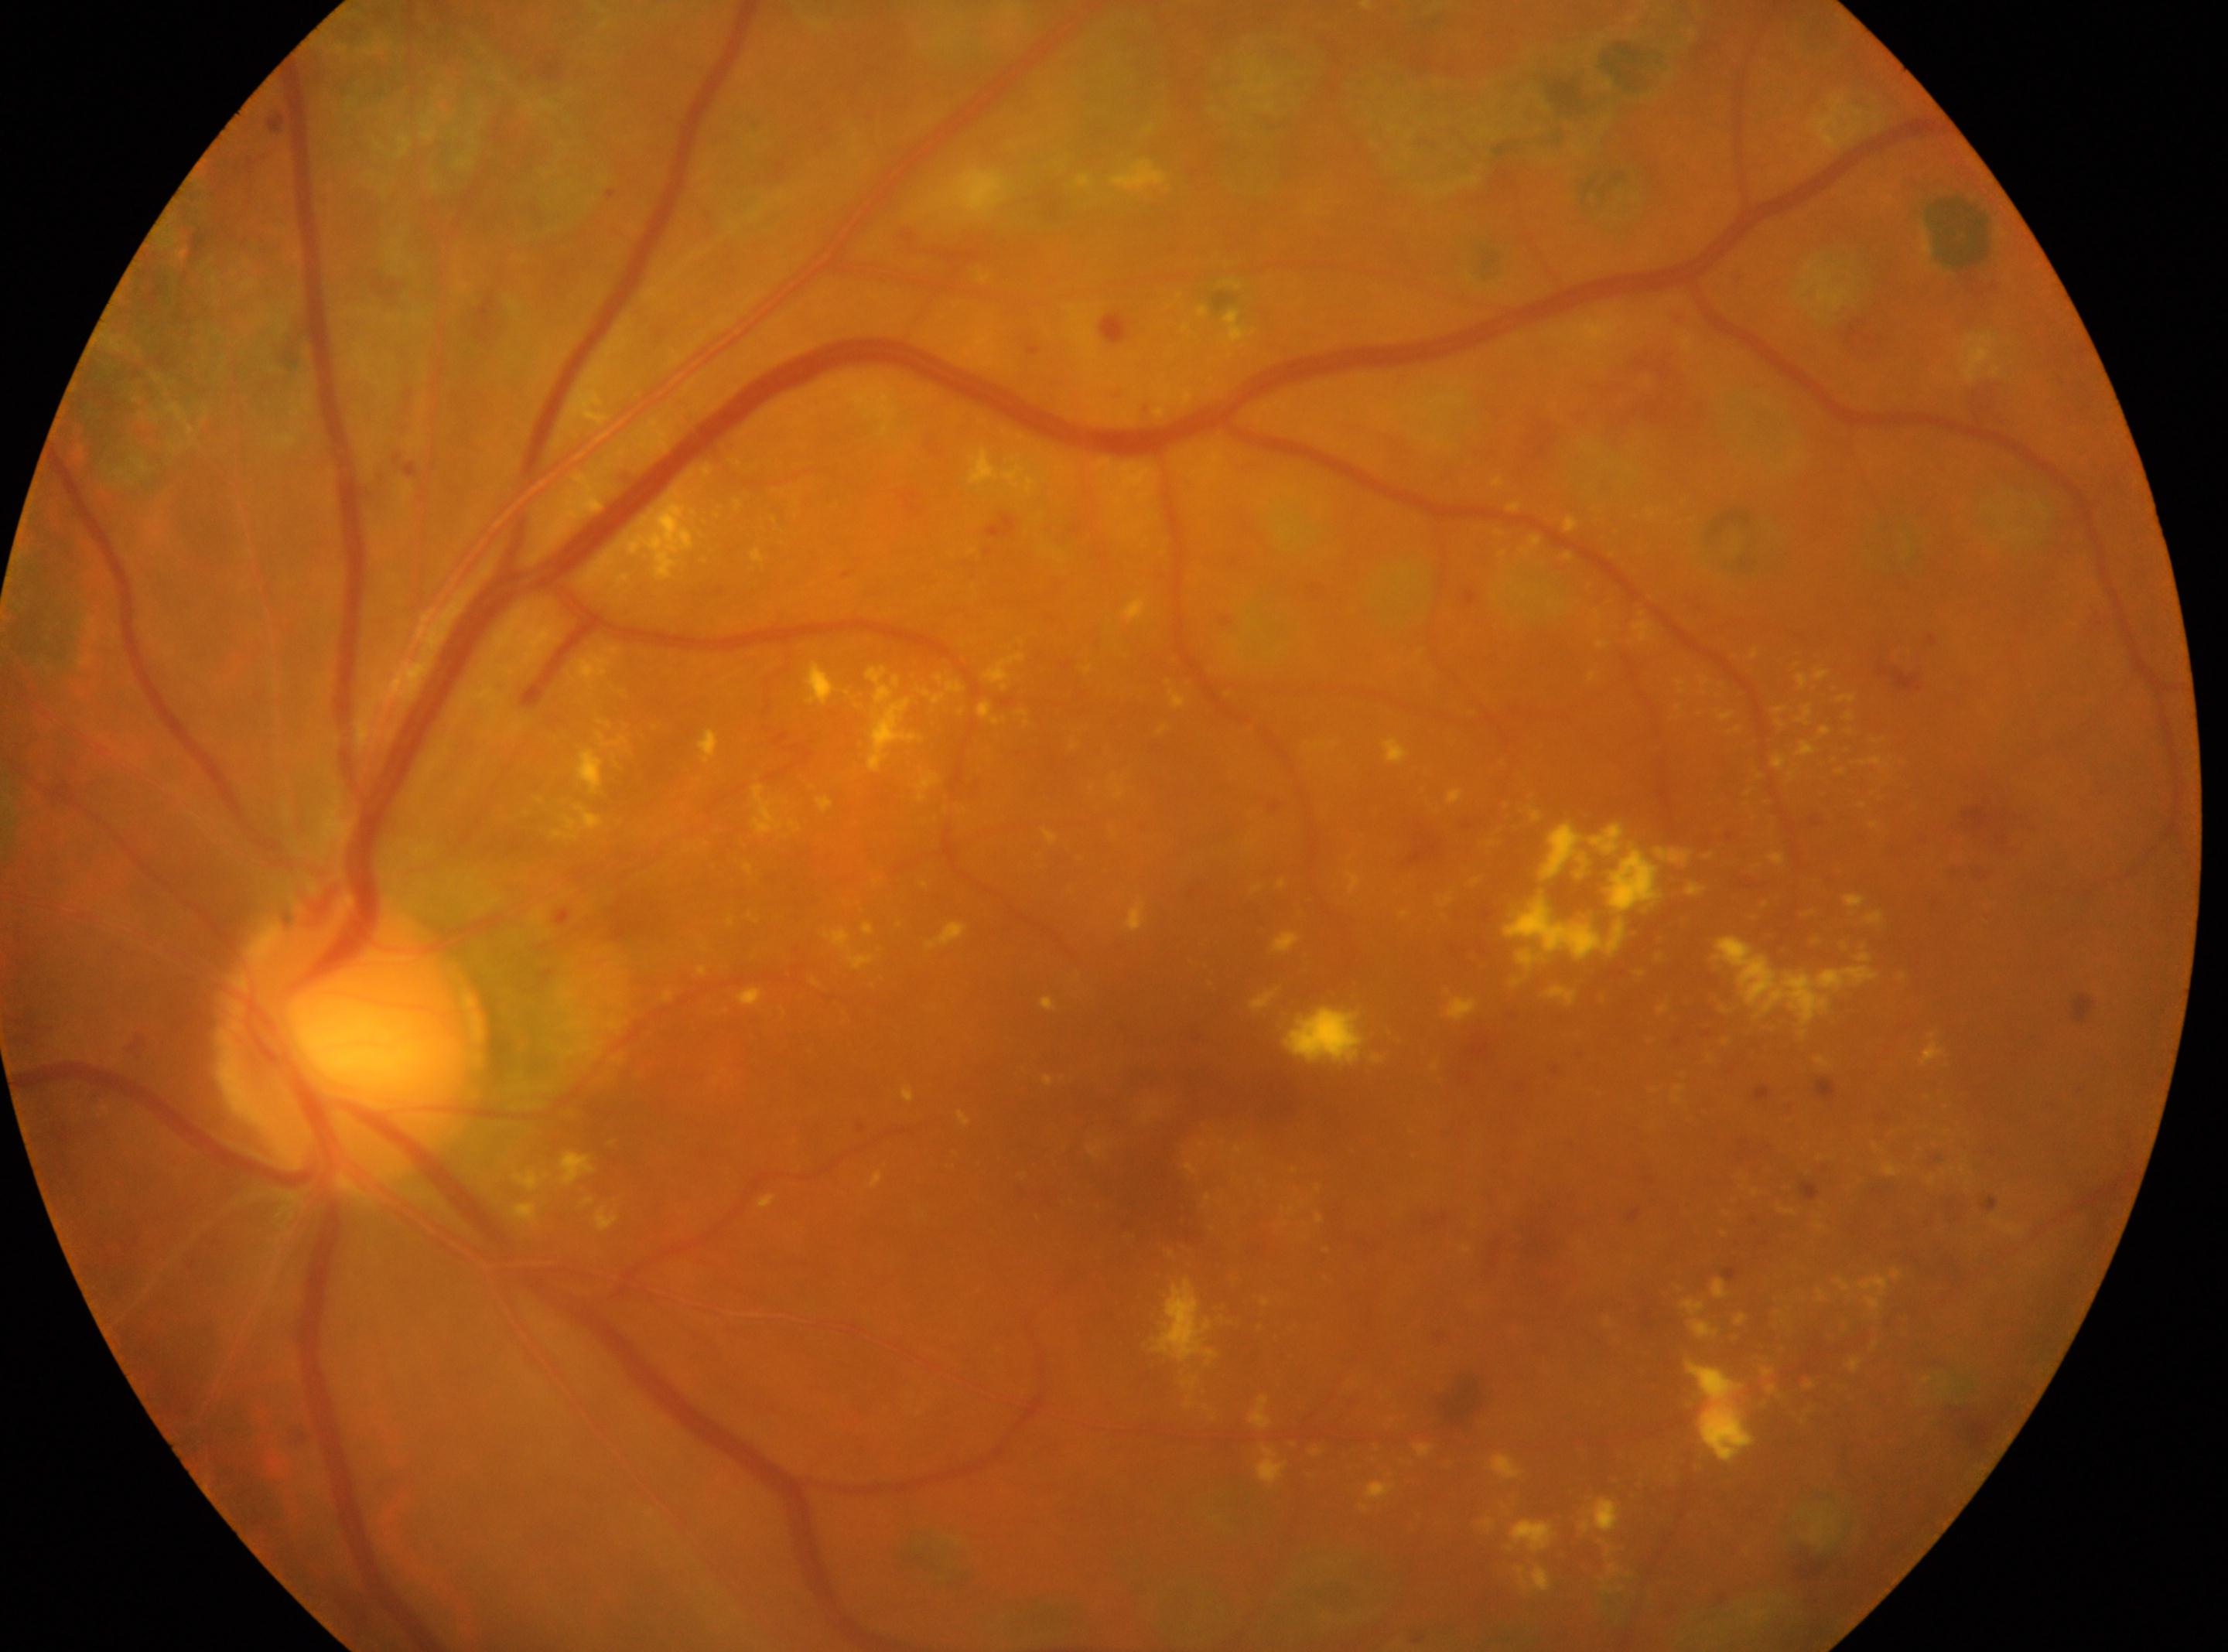

Fovea centralis: 1171, 1140. DR stage is post-photocoagulation DR, underlying severity severe non-proliferative diabetic retinopathy (grade 3). Disc center: 351, 1042. The image shows the OS.